640 x 480 pixels; wide-field fundus photograph from neonatal ROP screening; camera: Clarity RetCam 3 (130° FOV):
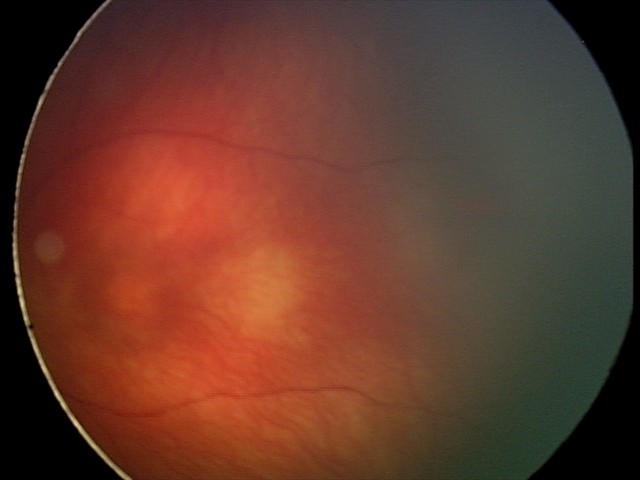
Screening diagnosis: retinal hemorrhages.